1659 by 2212 pixels
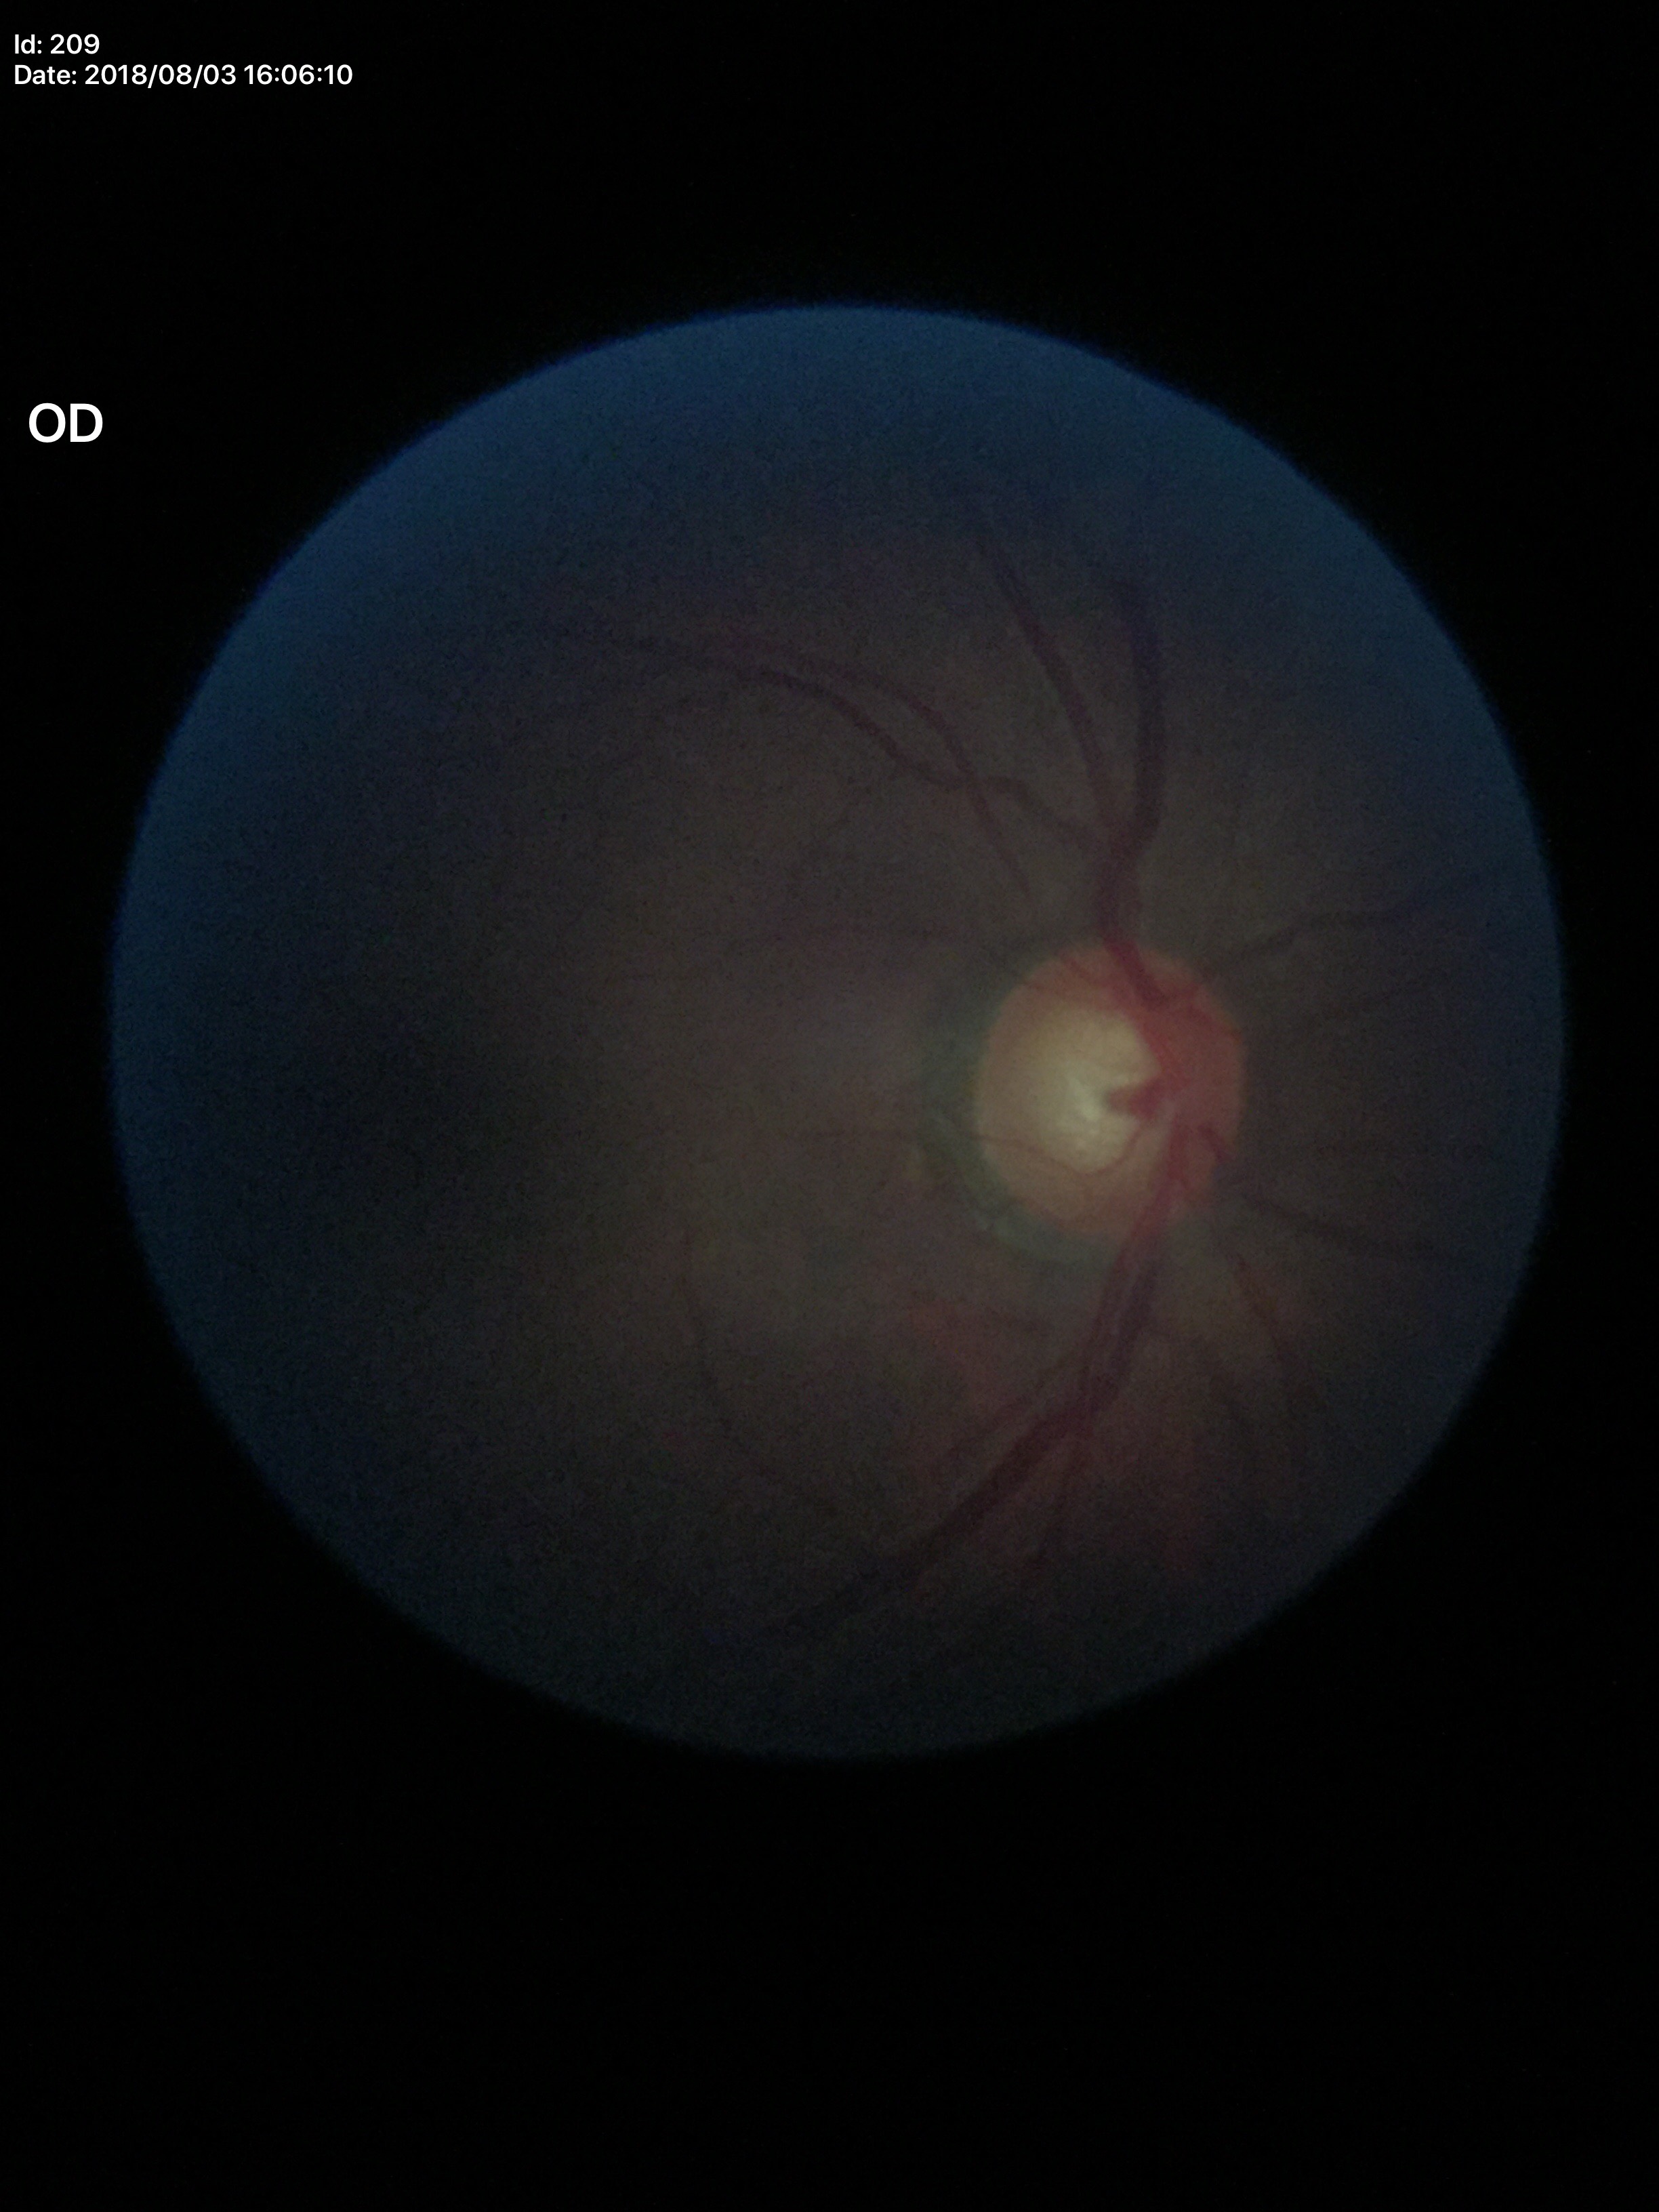
{
  "glaucoma_decision": "suspect",
  "vcdr": "0.67",
  "hcdr": "0.64"
}